Diabetic retinopathy graded by the modified Davis classification: 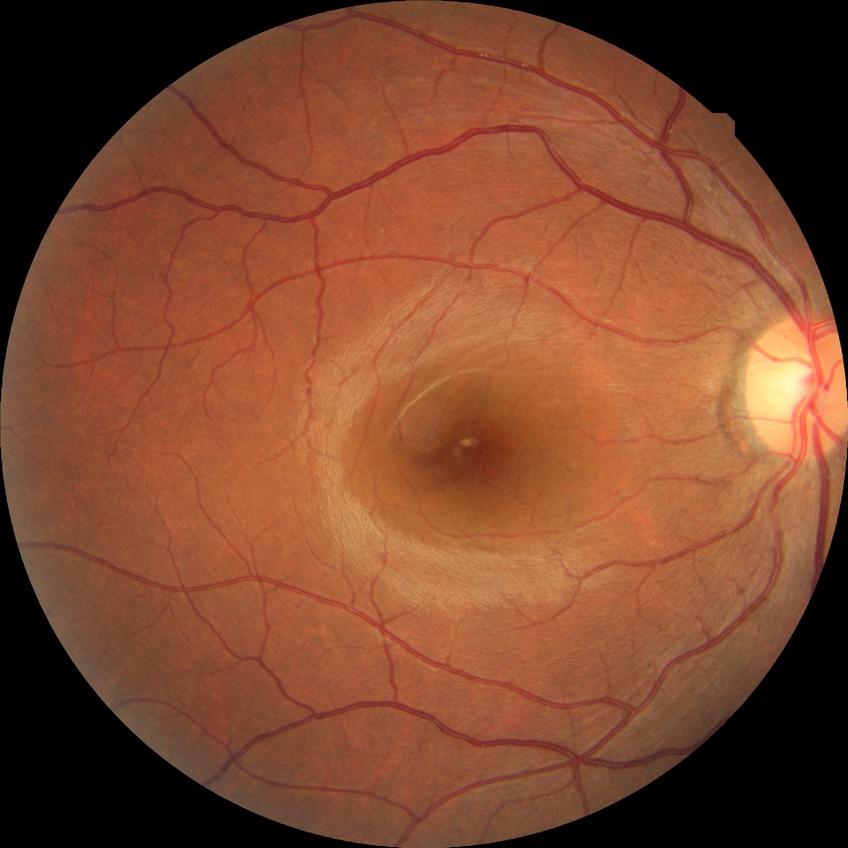 Diabetic retinopathy stage is no diabetic retinopathy.